Modified Davis classification:
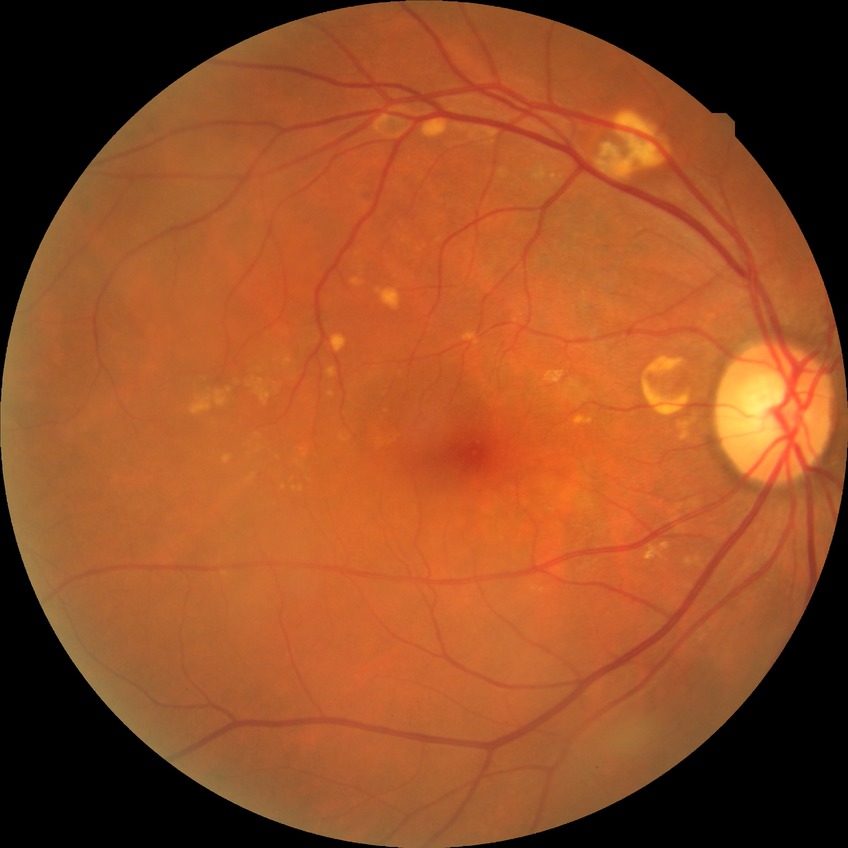

diabetic retinopathy (DR)@NDR (no diabetic retinopathy).